2184 x 1690 pixels
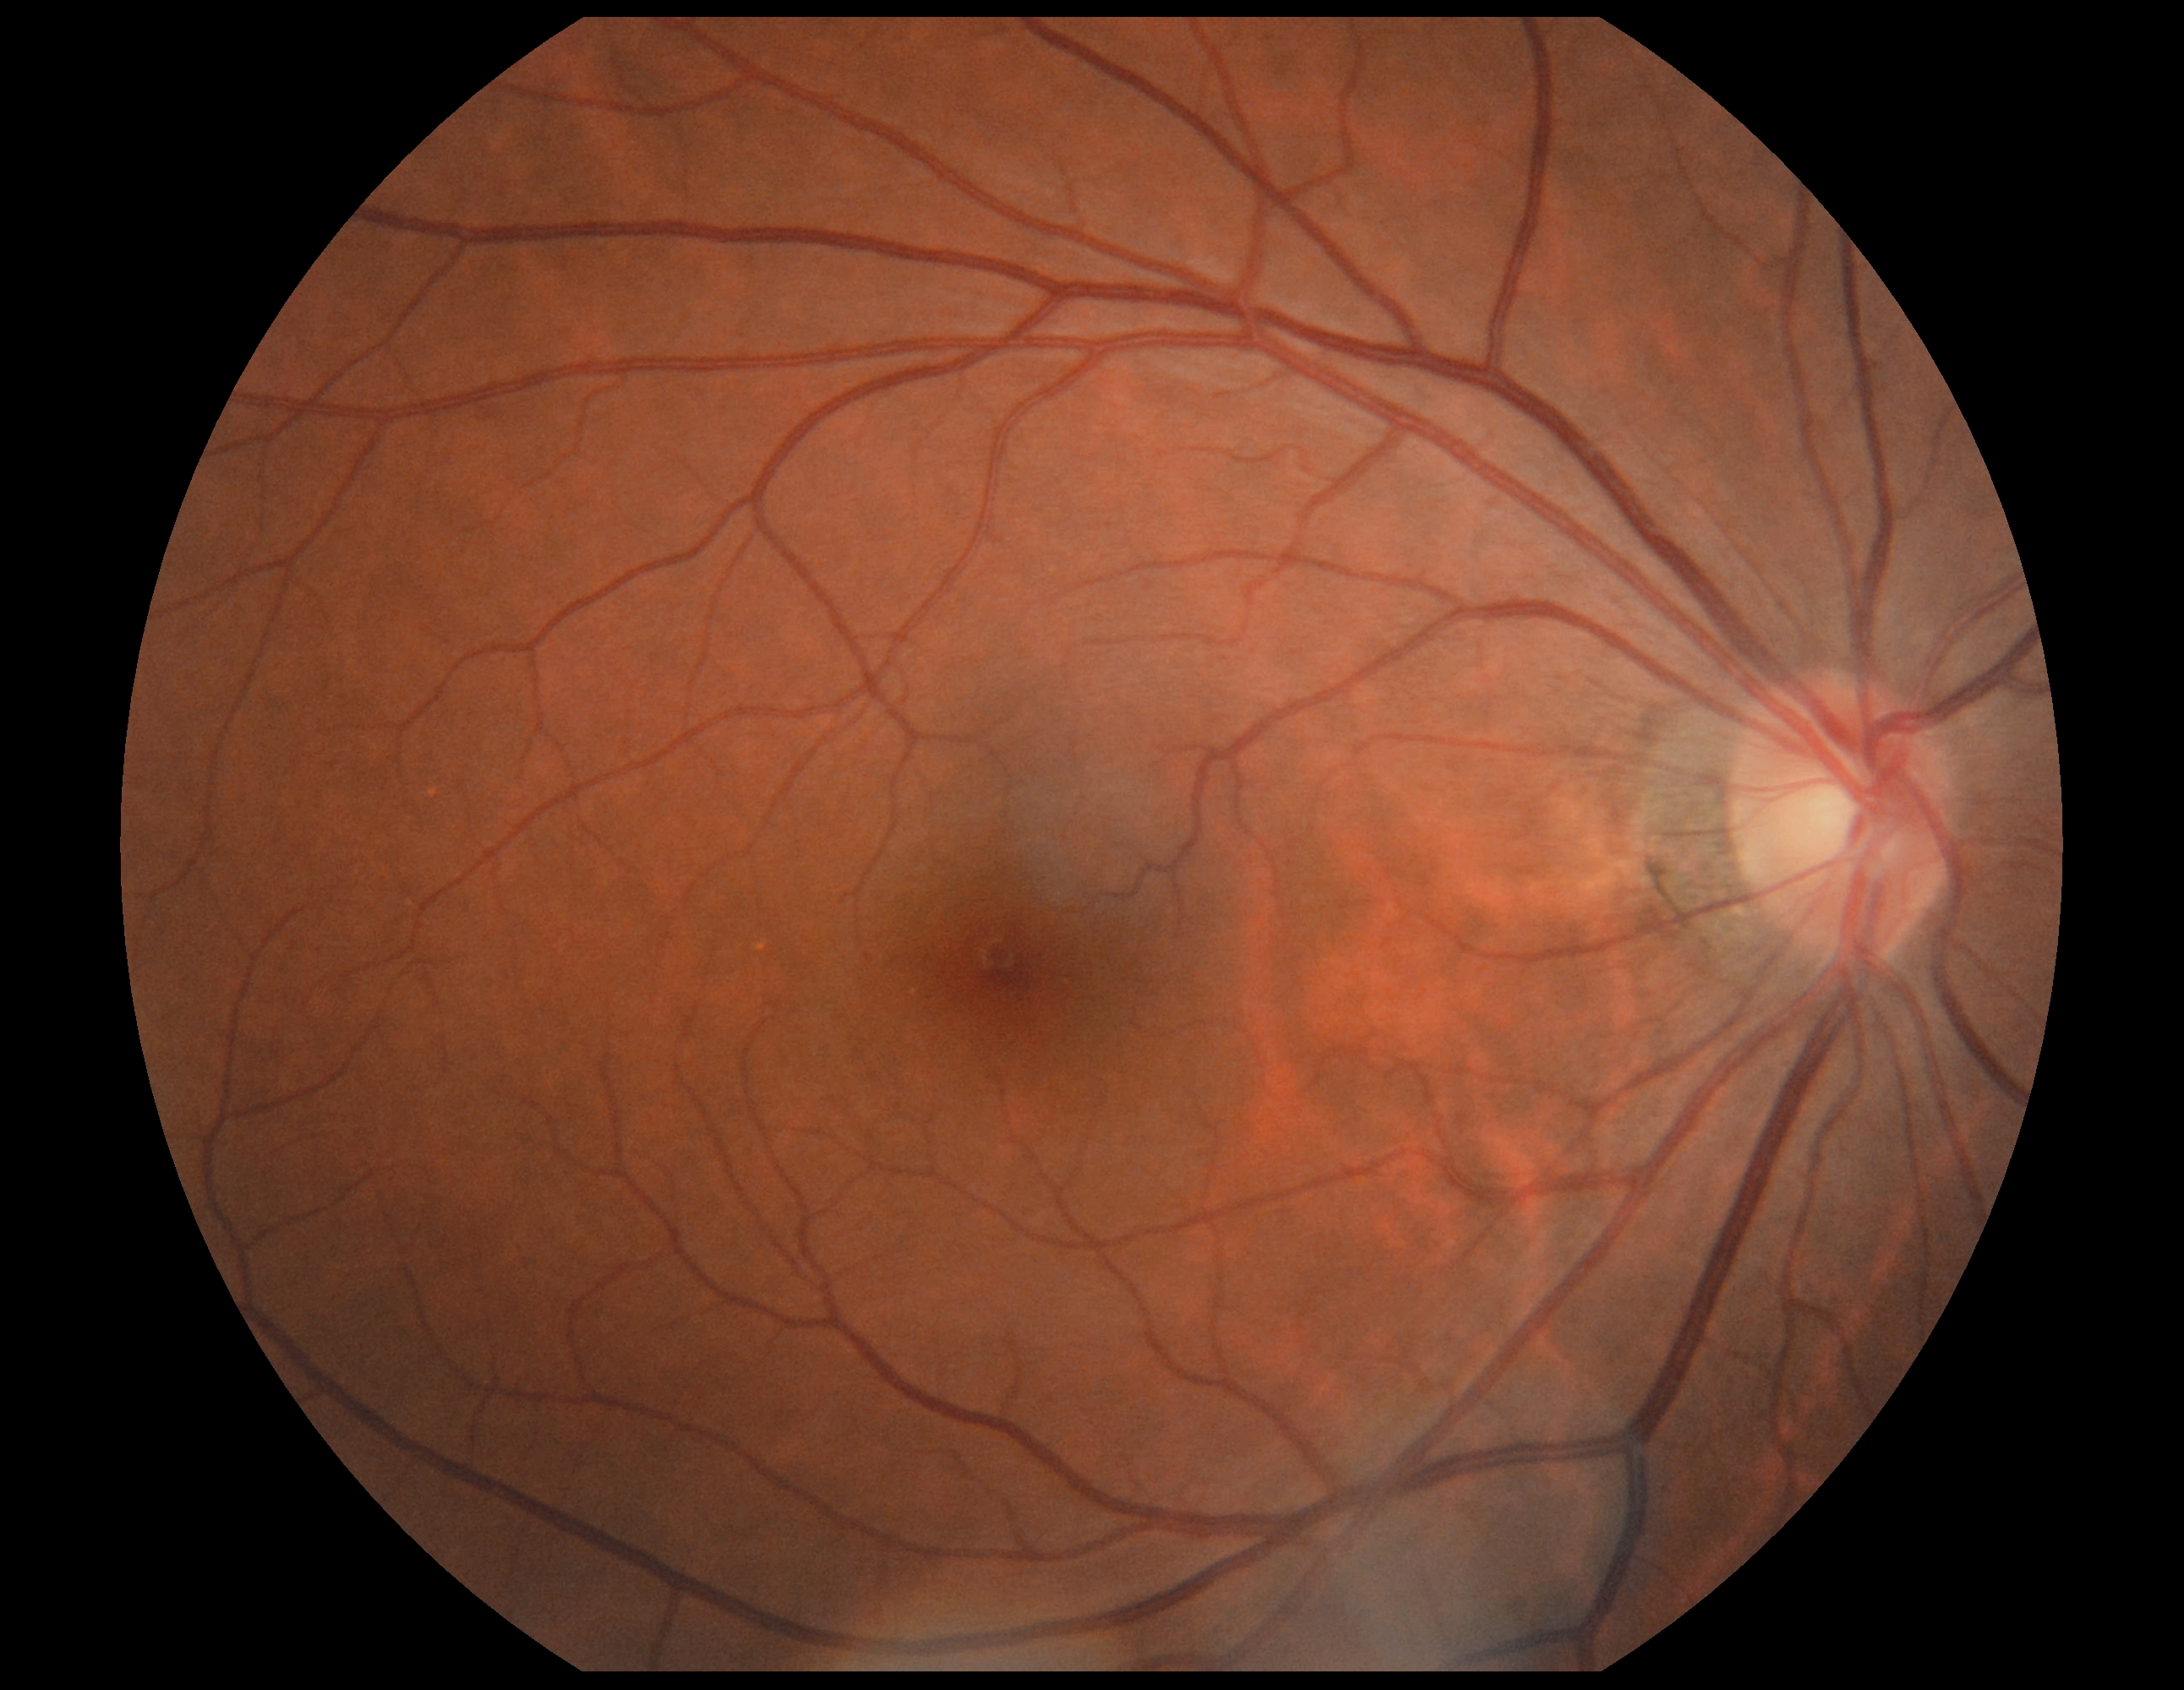
Findings:
- DR impression: no apparent DR
- retinopathy grade: 0/4